45-degree field of view. Modified Davis classification — 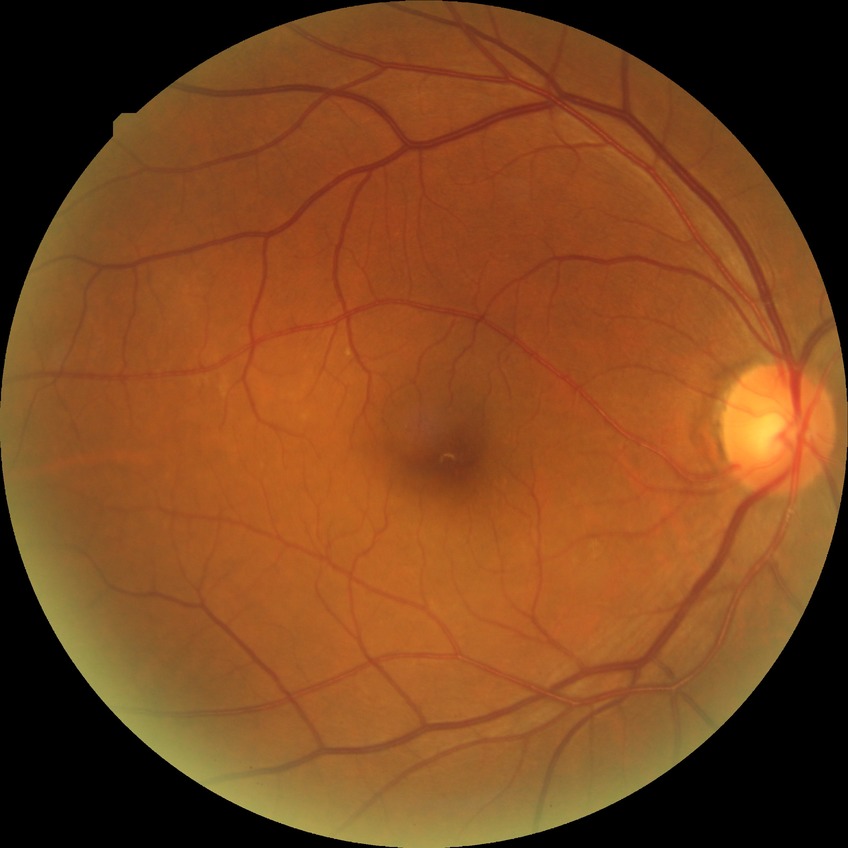
davis_grade: no diabetic retinopathy (NDR)